Camera: NIDEK AFC-230 · no pharmacologic dilation · color fundus photograph · 848 x 848 pixels — 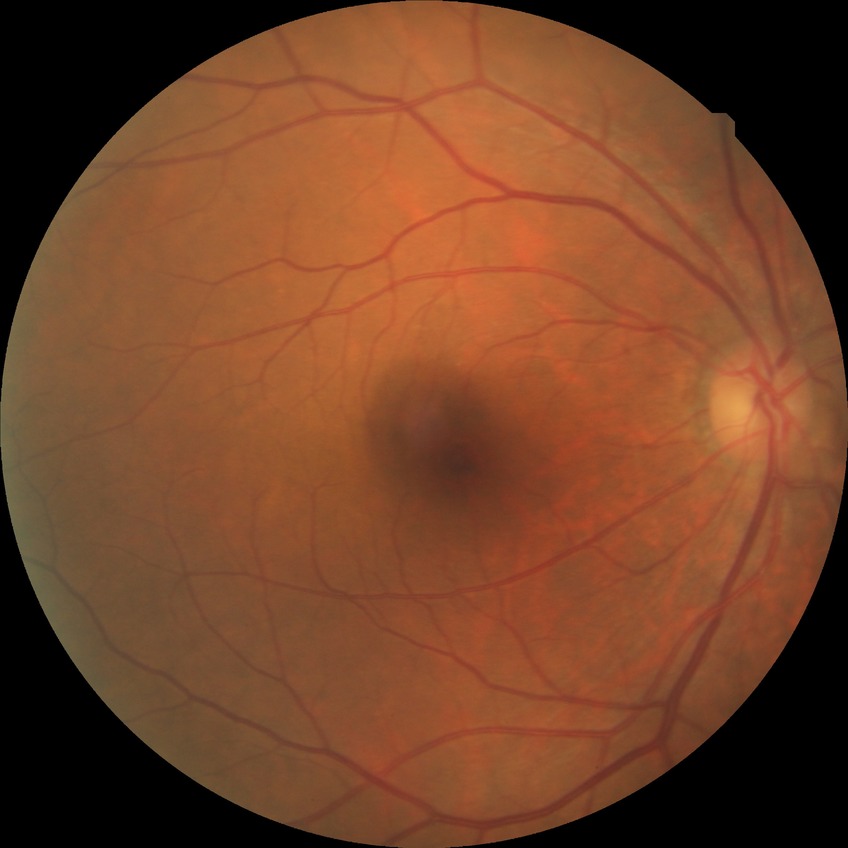 DR class: non-proliferative diabetic retinopathy
diabetic retinopathy (DR): simple diabetic retinopathy (SDR)